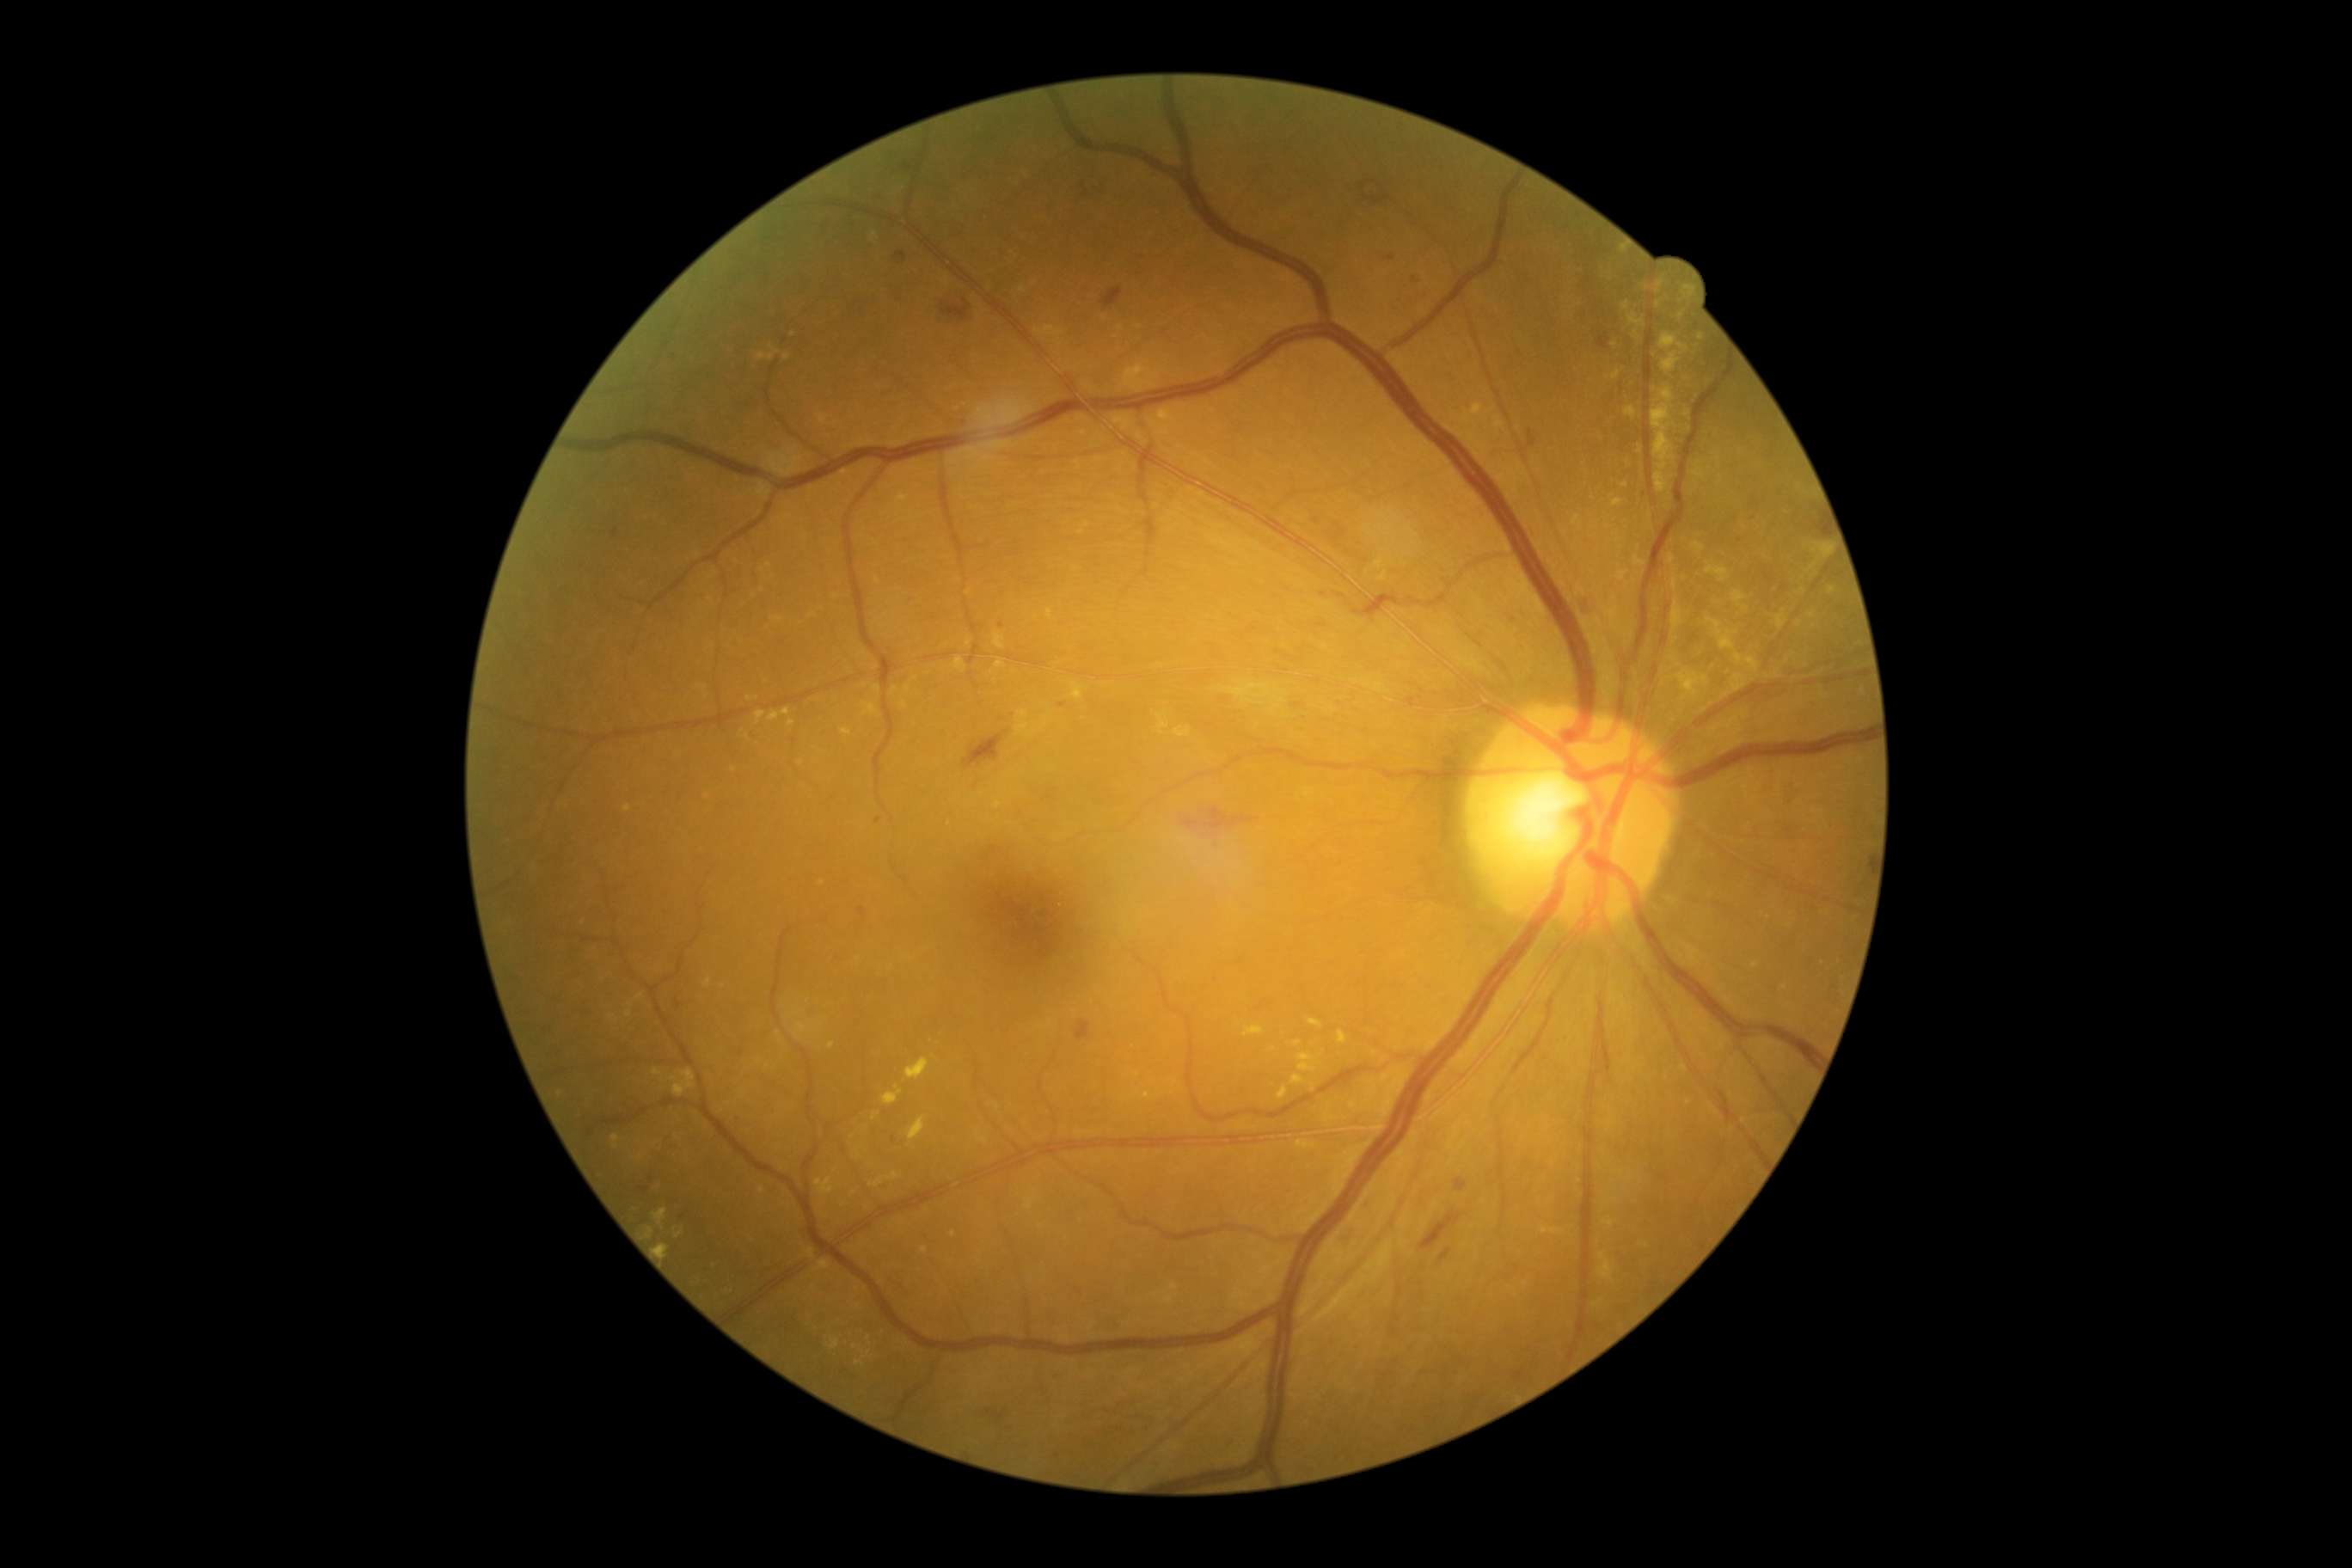 <lesions partial="true">
  <dr_grade>2</dr_grade>
  <ex partial="true">(x1=1729, y1=718, x2=1739, y2=723), (x1=1734, y1=591, x2=1746, y2=604), (x1=757, y1=352, x2=778, y2=362), (x1=1612, y1=371, x2=1622, y2=381), (x1=1297, y1=1053, x2=1318, y2=1072), (x1=646, y1=1228, x2=654, y2=1239), (x1=788, y1=720, x2=795, y2=728), (x1=995, y1=634, x2=1005, y2=651), (x1=768, y1=711, x2=780, y2=721), (x1=1722, y1=675, x2=1748, y2=701), (x1=1705, y1=561, x2=1729, y2=582)</ex>
  <ex_small>x=699, y=688, x=1606, y=527, x=1650, y=518, x=876, y=688, x=1746, y=608, x=866, y=686, x=1777, y=674</ex_small>
</lesions>